Wide-field fundus photograph of an infant; 1240x1240px; 100° field of view (Phoenix ICON)
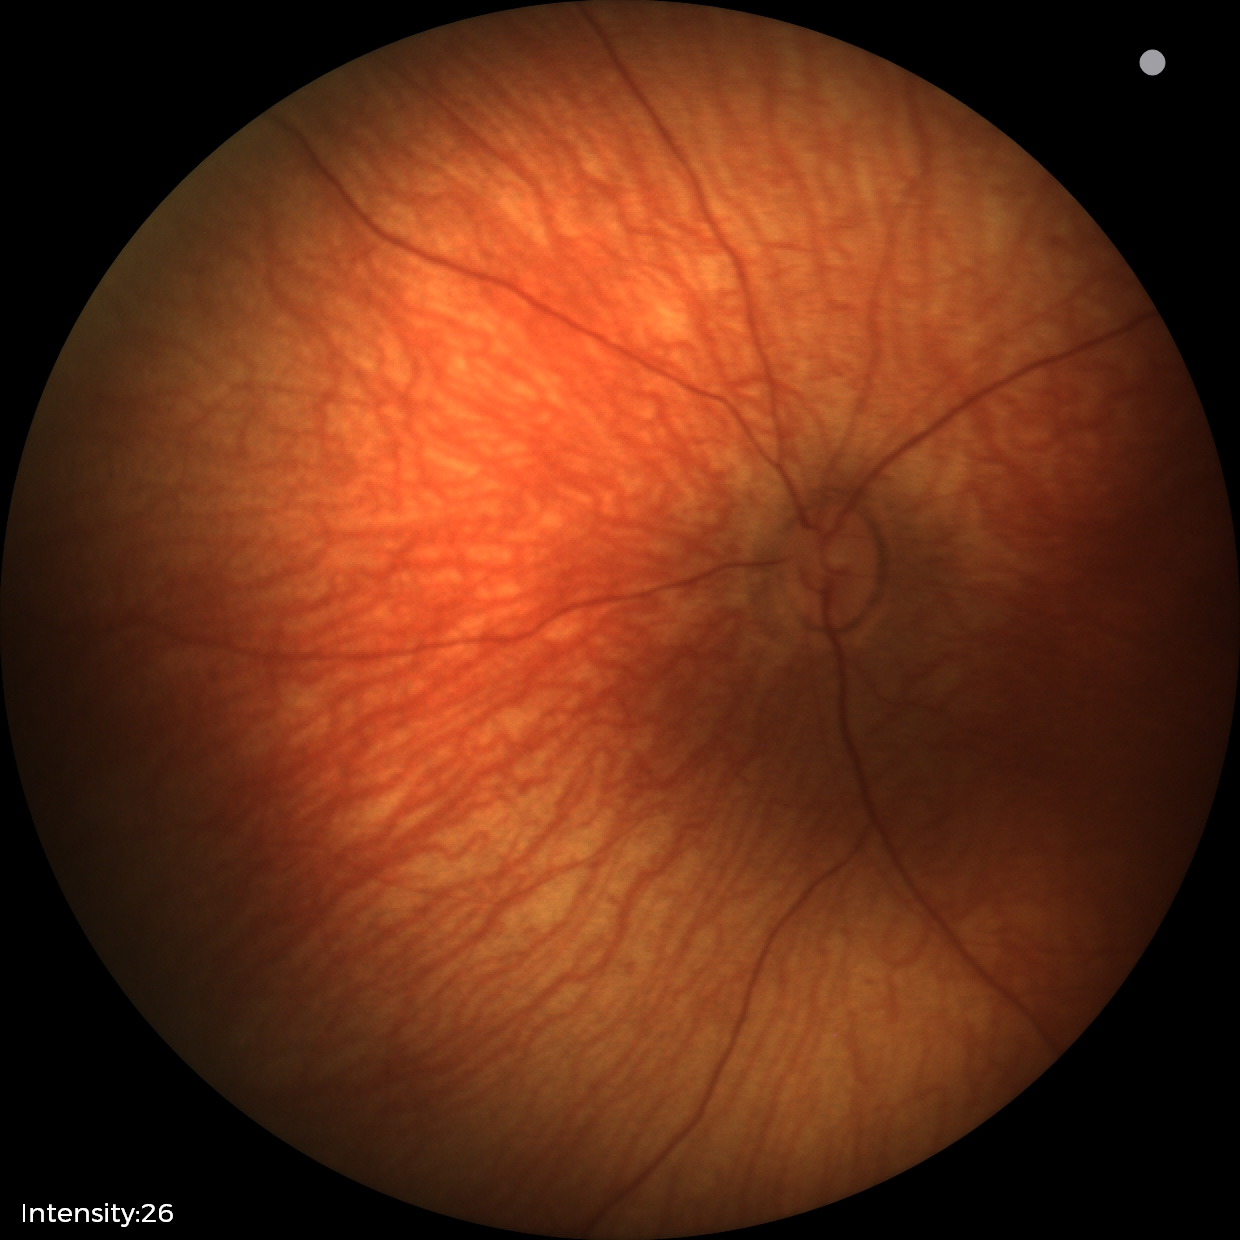

Physiological retinal appearance for postconceptual age.